Acquired with a NIDEK AFC-230. Posterior pole color fundus photograph. No pharmacologic dilation.
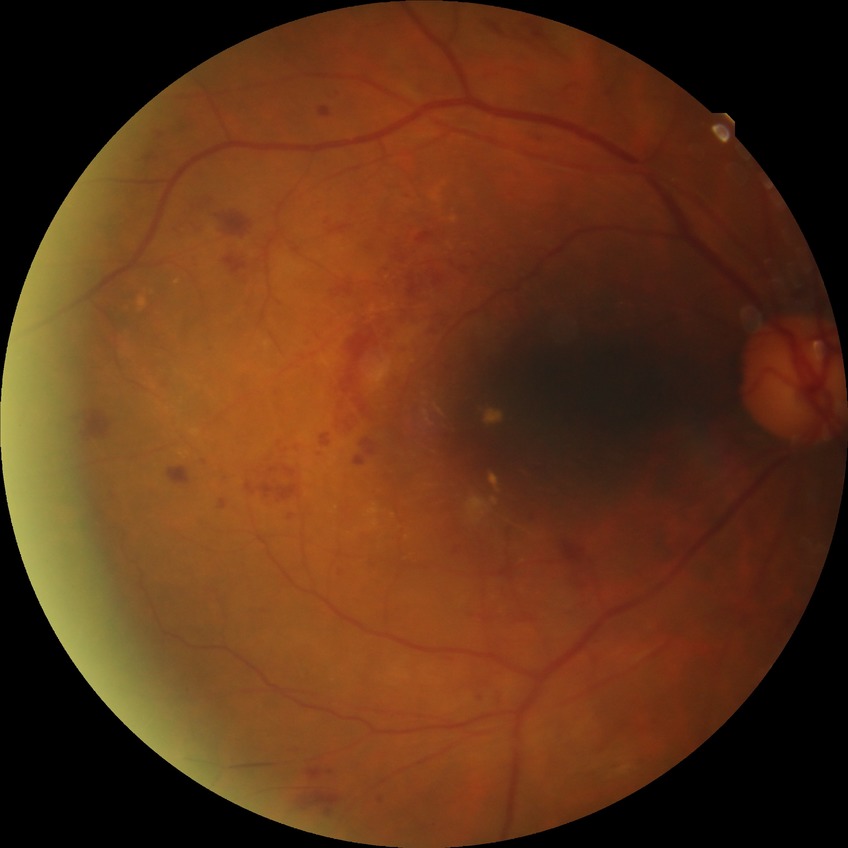

DR class: non-proliferative diabetic retinopathy. Diabetic retinopathy severity: pre-proliferative diabetic retinopathy.